Retinal fundus photograph, 45-degree field of view.
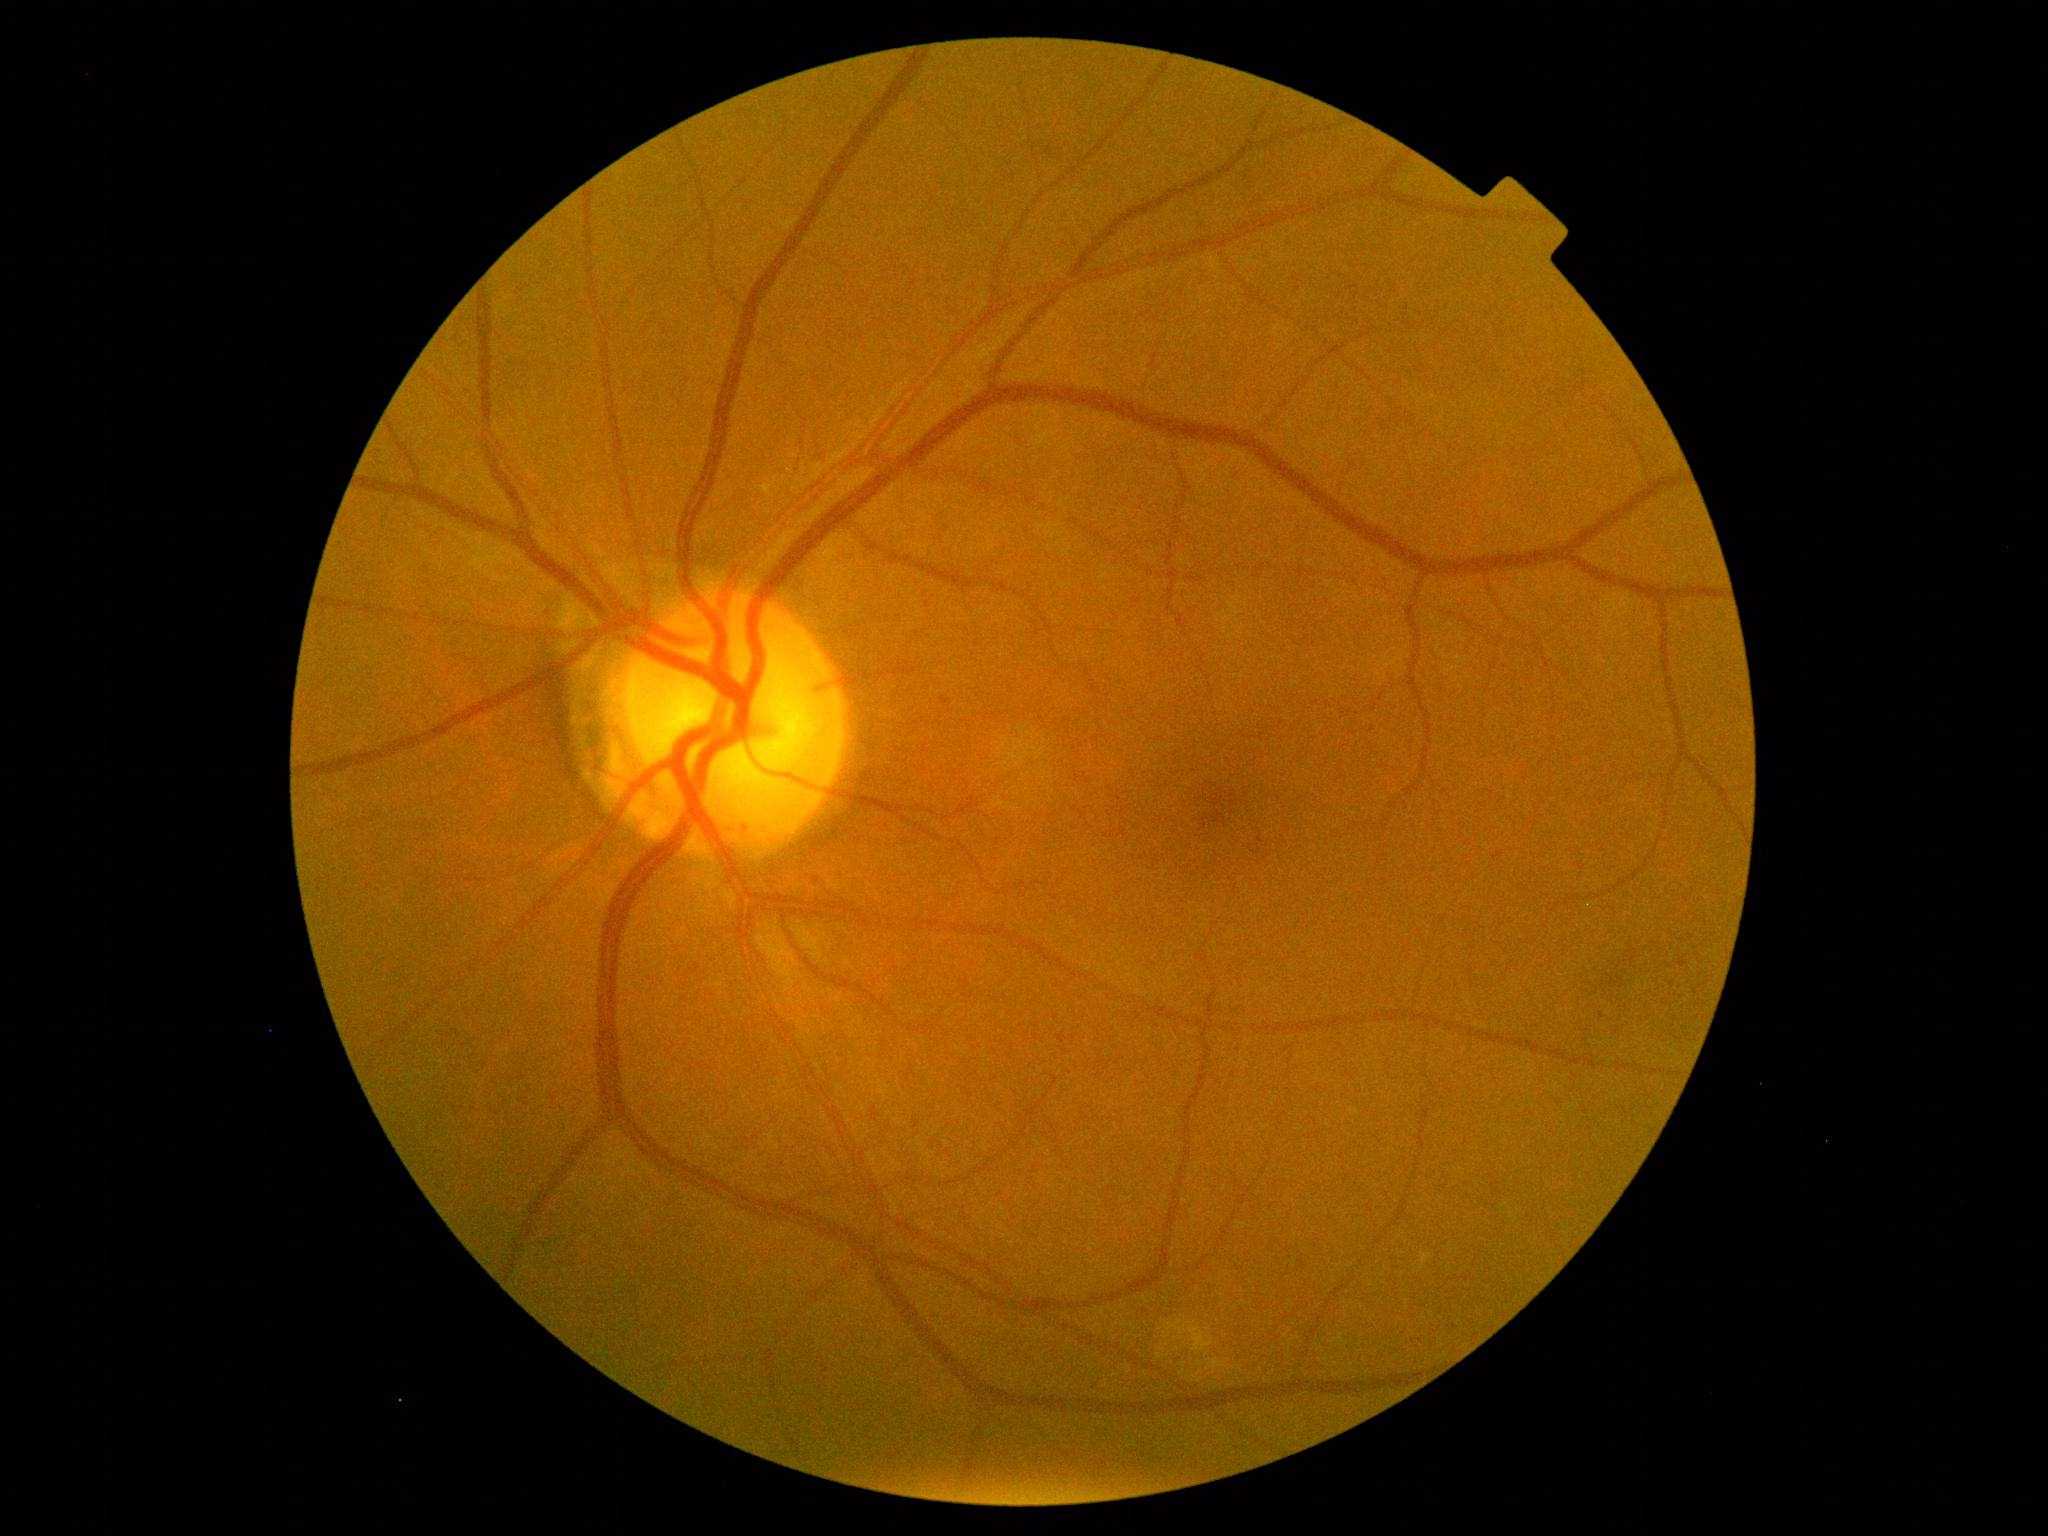

Diabetic retinopathy (DR) is 1/4.